45-degree field of view — 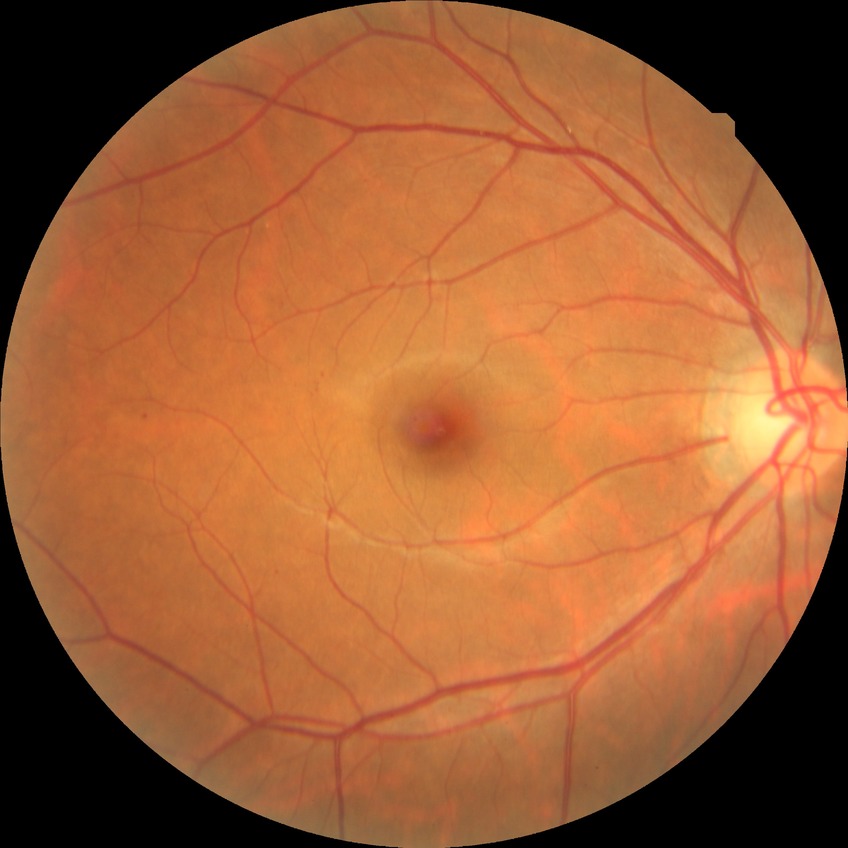

Diabetic retinopathy (DR): simple diabetic retinopathy (SDR).